Retinal fundus photograph — 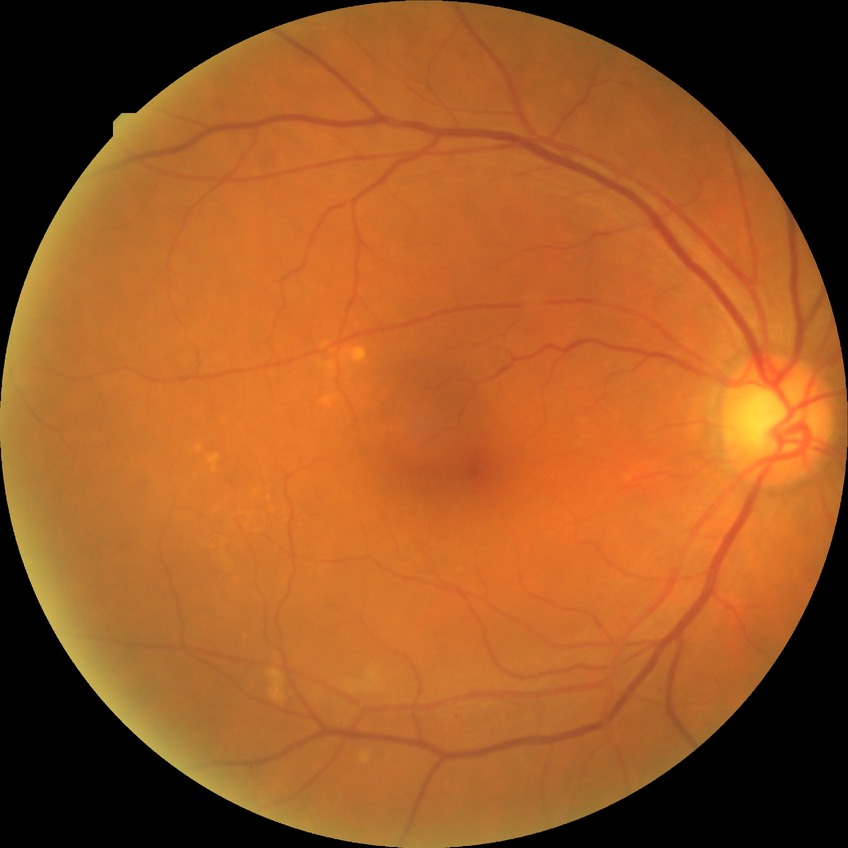
Retinopathy grade: no diabetic retinopathy.